45-degree field of view. 1536 by 1152 pixels.
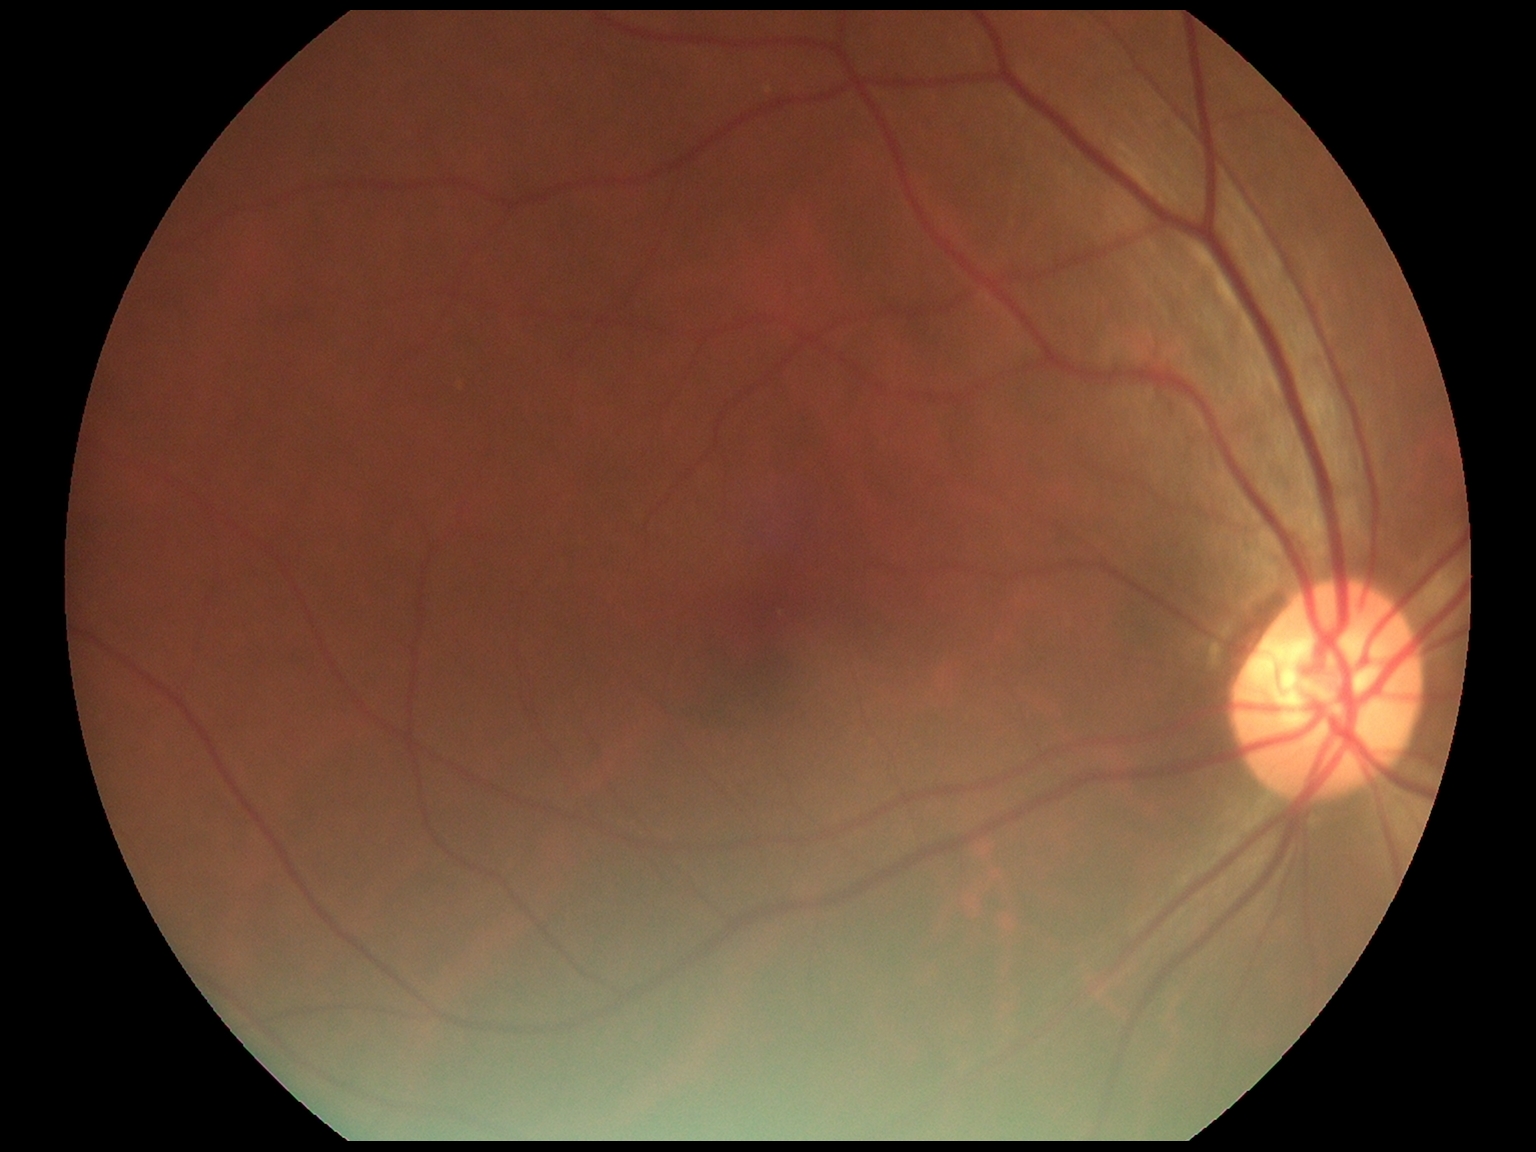
Diabetic retinopathy (DR) is grade 0.